848 by 848 pixels · NIDEK AFC-230 · DR severity per modified Davis staging.
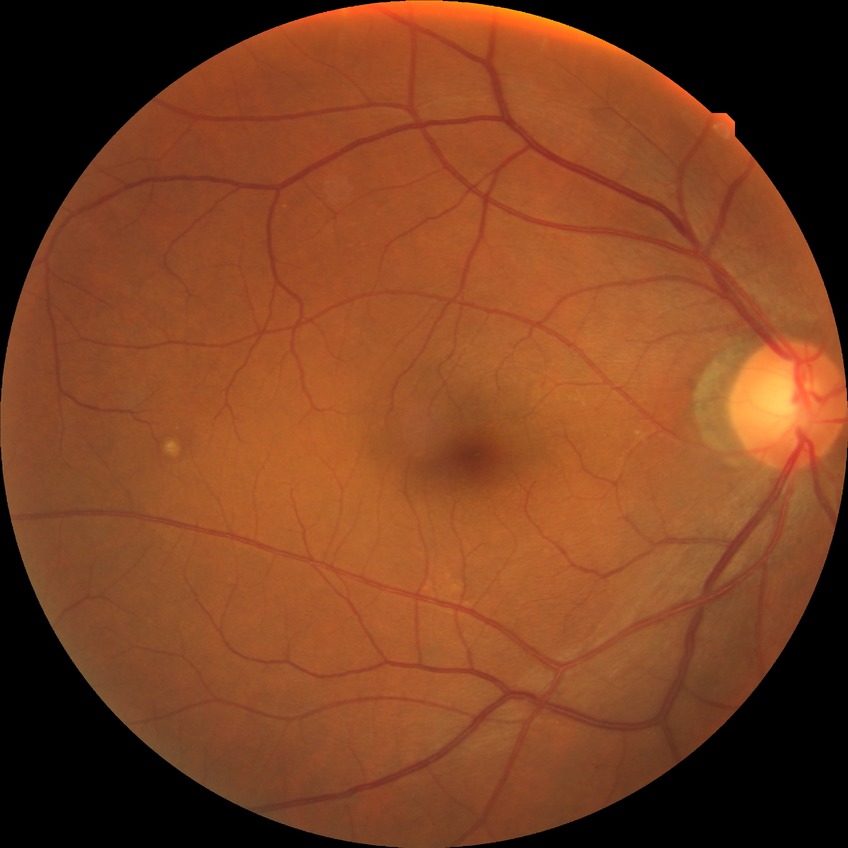
Davis grading: no diabetic retinopathy.